Pediatric retinal photograph (wide-field); Phoenix ICON, 100° FOV.
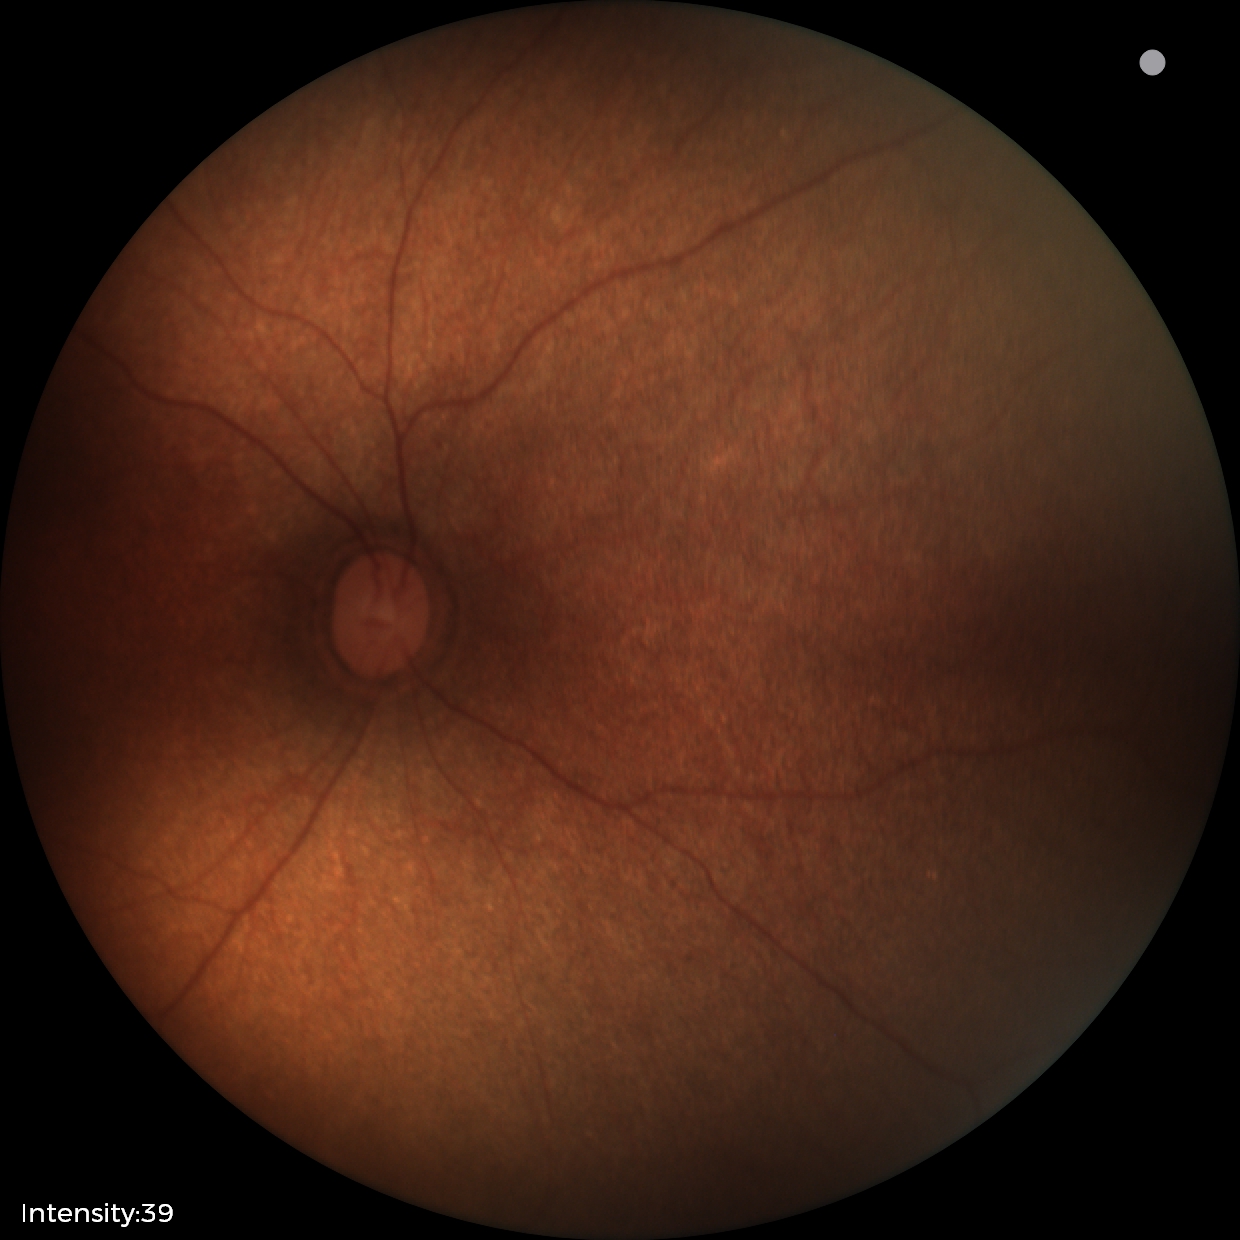
Screening examination with no abnormal retinal findings.